1659x2212px · retinal fundus photograph · Remidio FOP fundus camera — 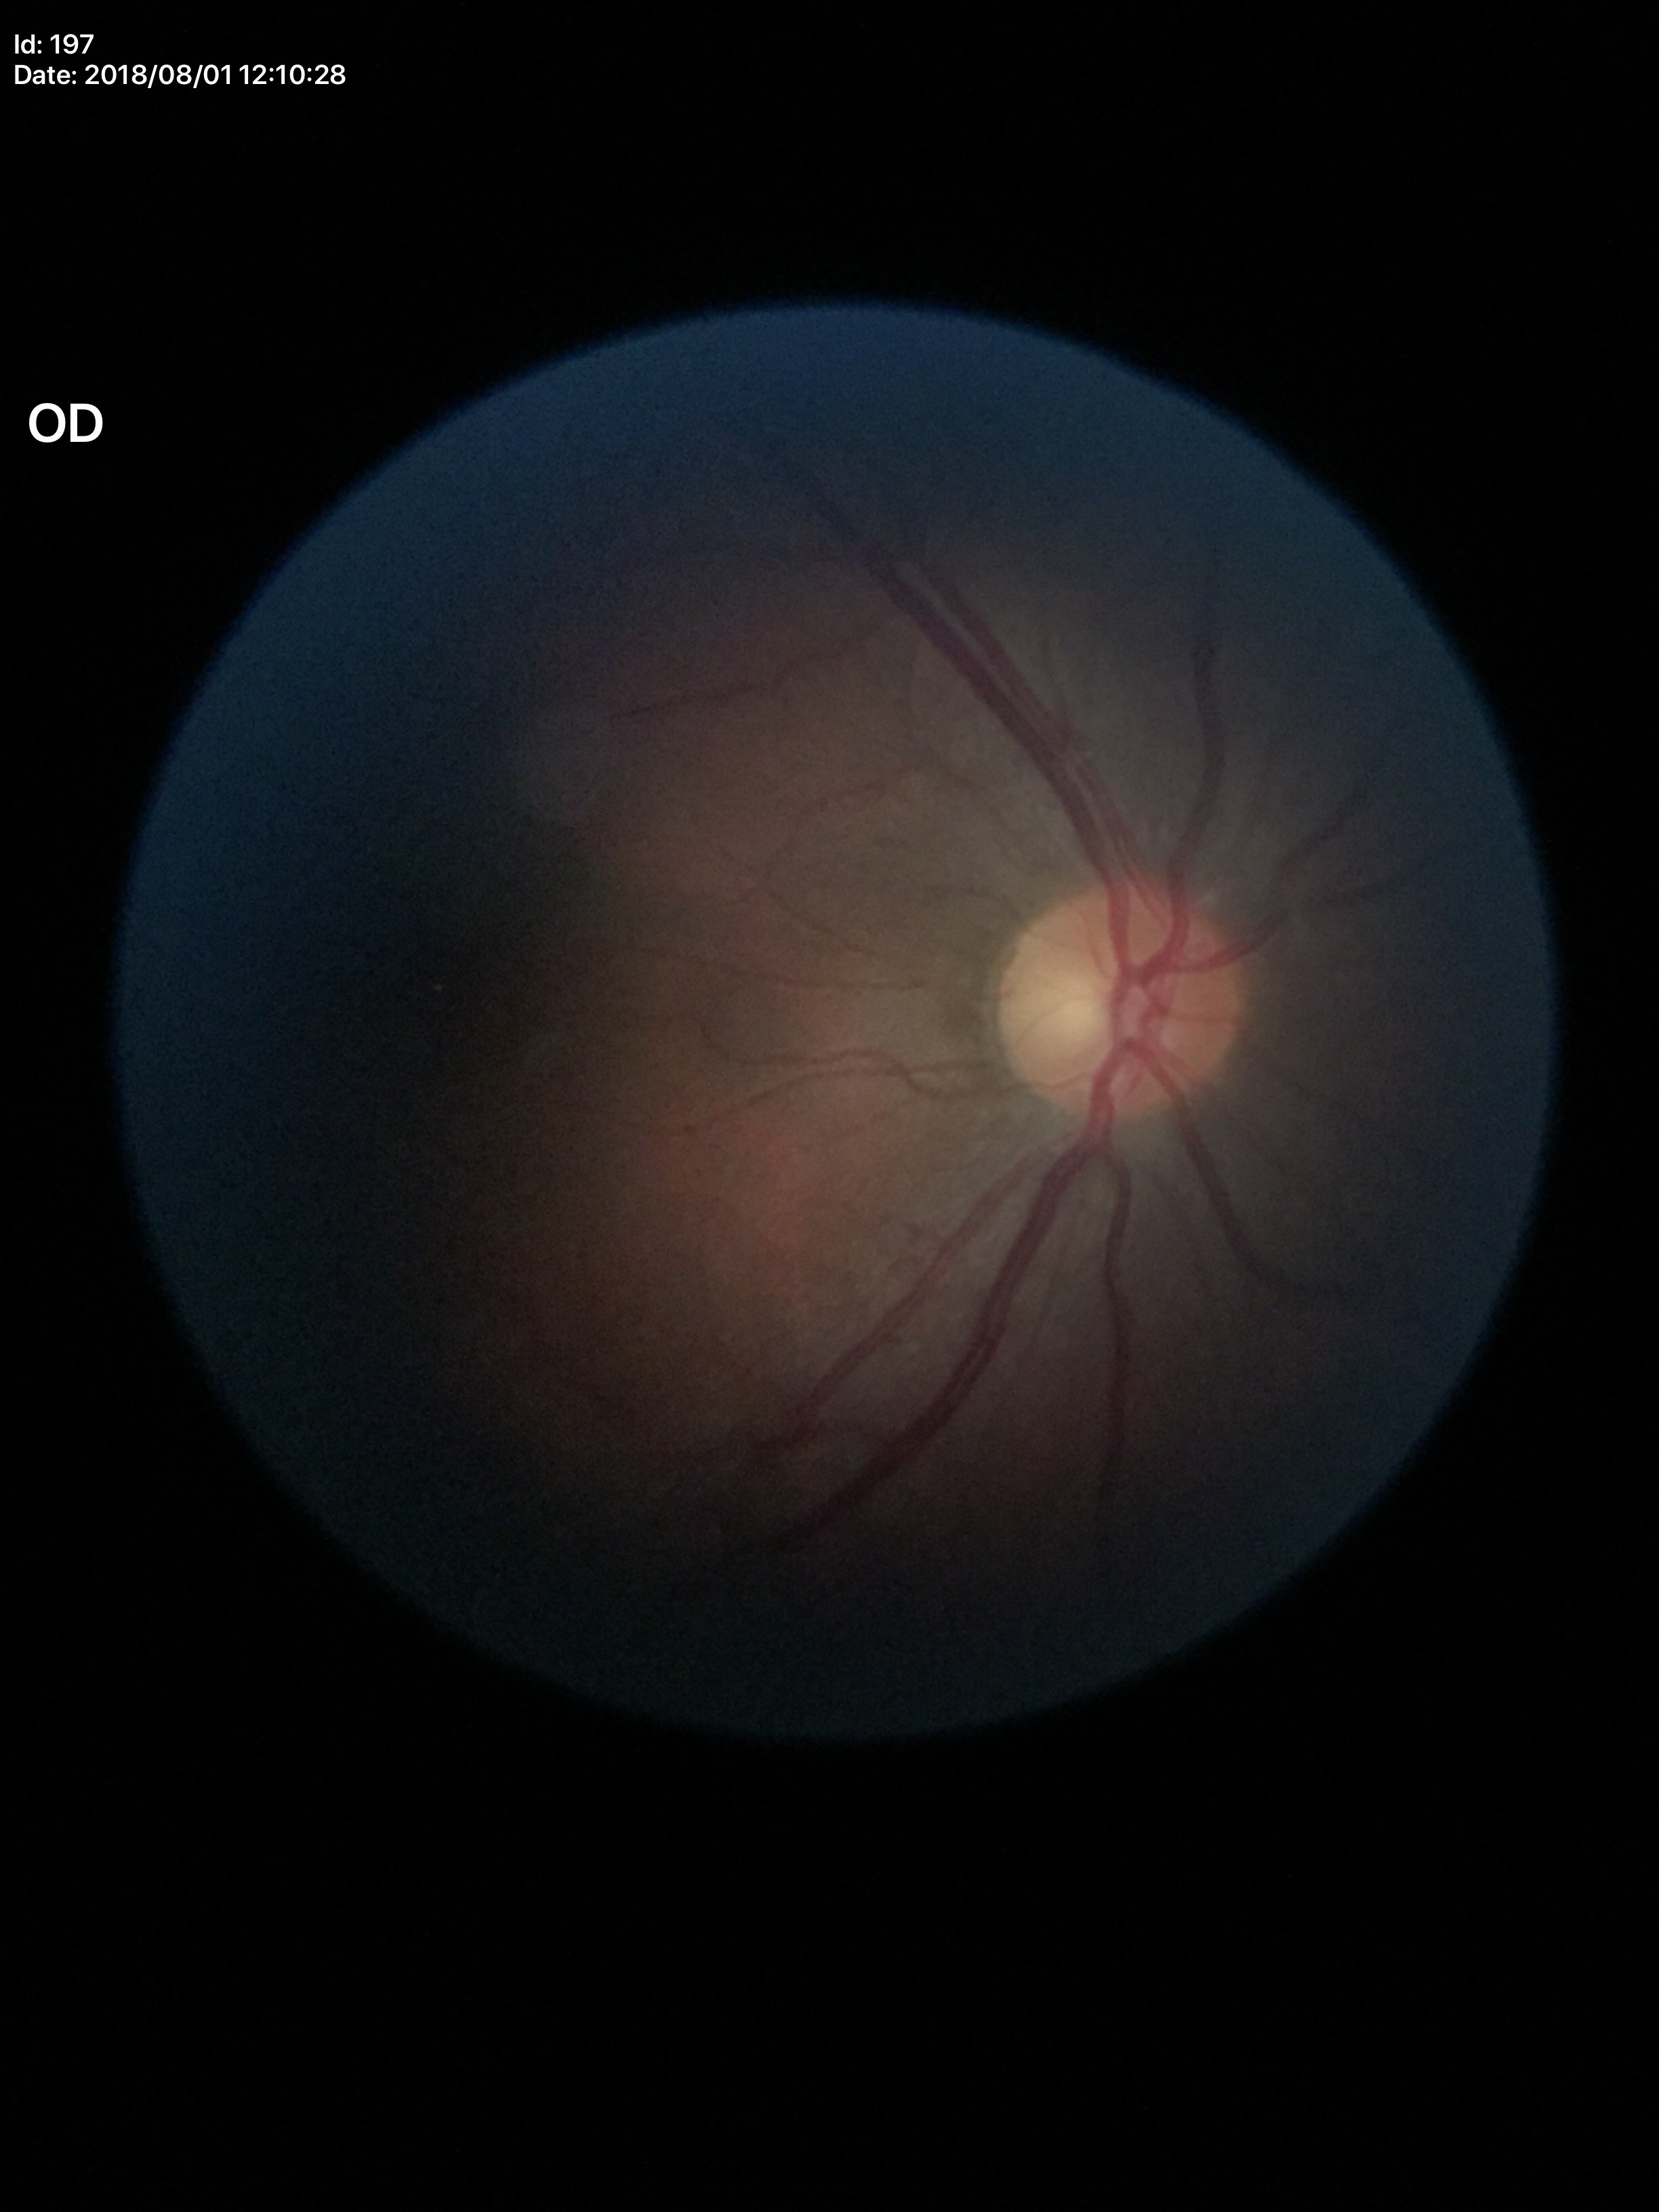
Not suspicious for glaucoma.
Vertical CDR (VCDR) of 0.51.
Horizontal cup-to-disc ratio (HCDR) is 0.52.